Acquired on the Clarity RetCam 3. Pediatric wide-field fundus photograph: 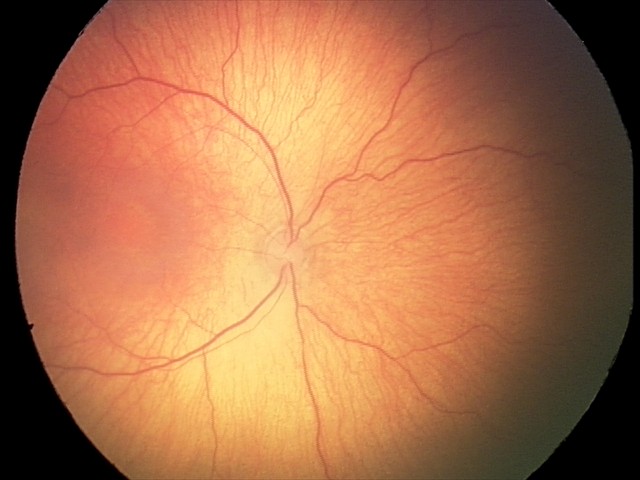

No plus disease. From an examination with diagnosis of retinopathy of prematurity (ROP) stage 1.